Wide-field fundus photograph of an infant. 640 x 480 pixels — 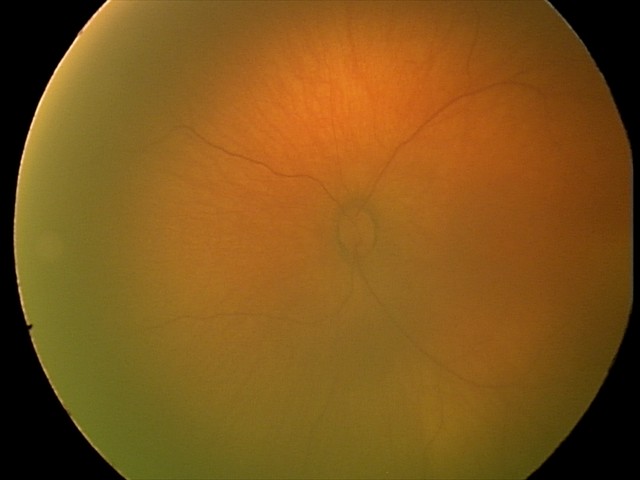

Screening diagnosis: physiological finding.